Wide-field contact fundus photograph of an infant; 640x480px; 130° field of view (Clarity RetCam 3):
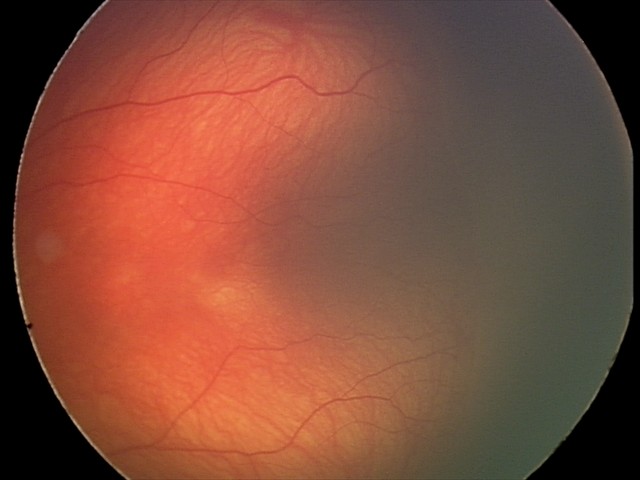

Q: What is the plus-form classification?
A: no plus disease
Q: What is the screening diagnosis?
A: retinopathy of prematurity stage 2 — ridge with height and width at the demarcation line